Camera: NIDEK AFC-230, 45 degree fundus photograph: 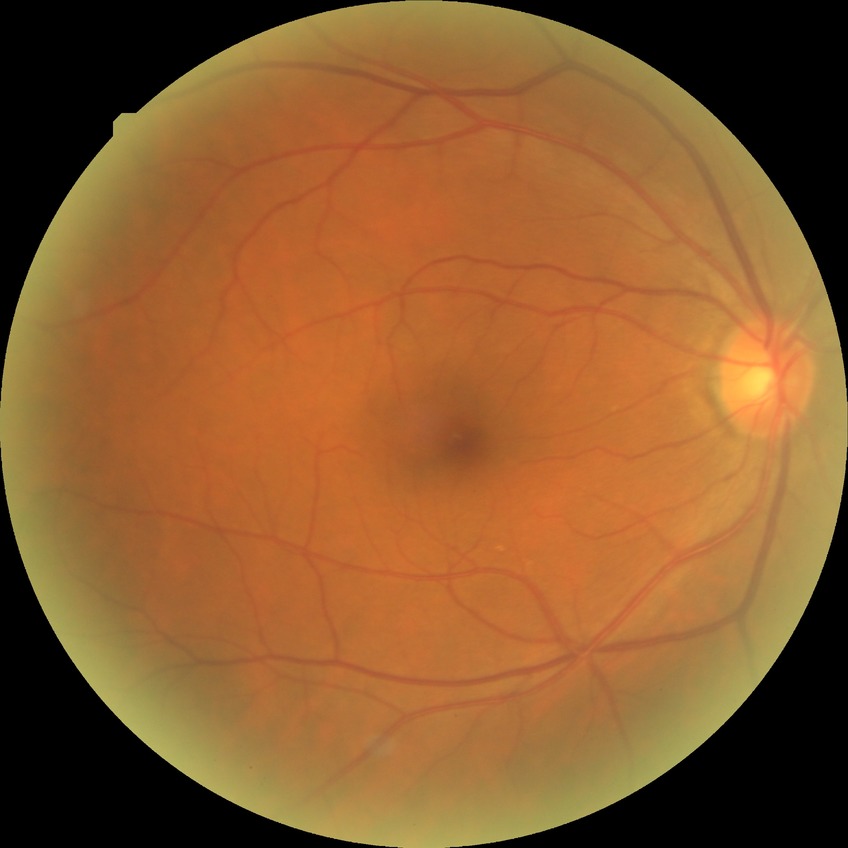 {
  "davis_grade": "no diabetic retinopathy"
}